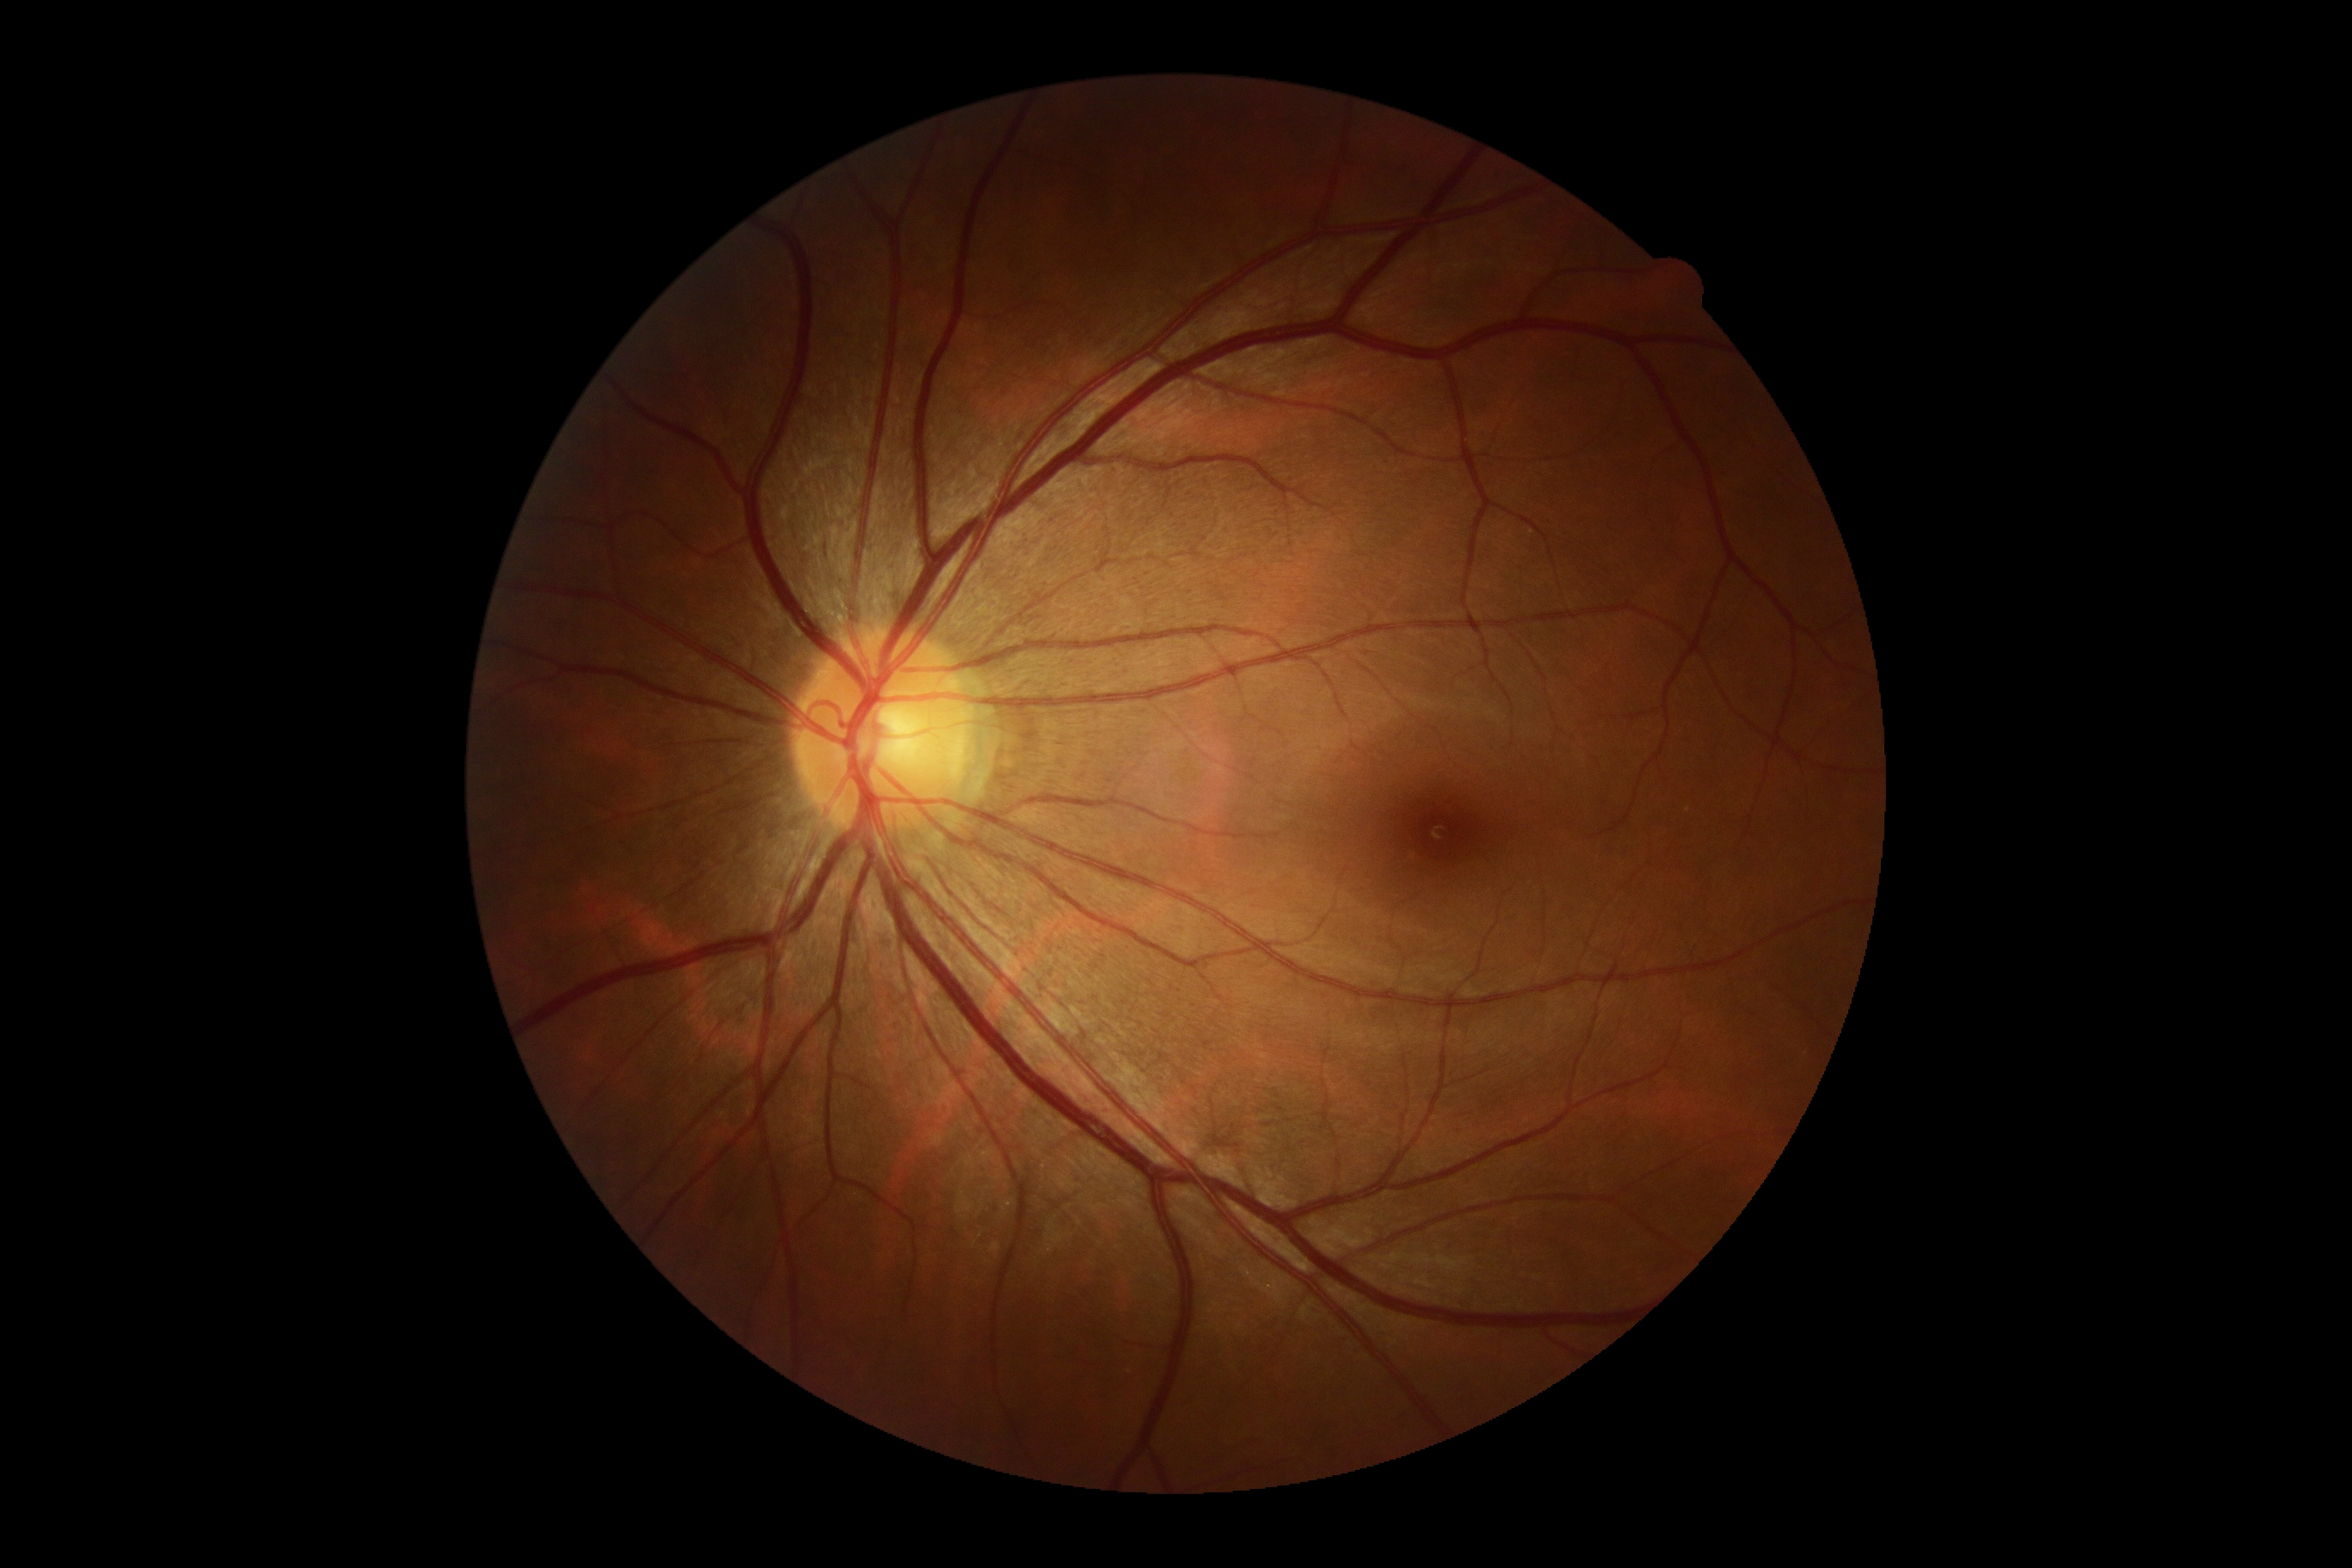 DR: 0.